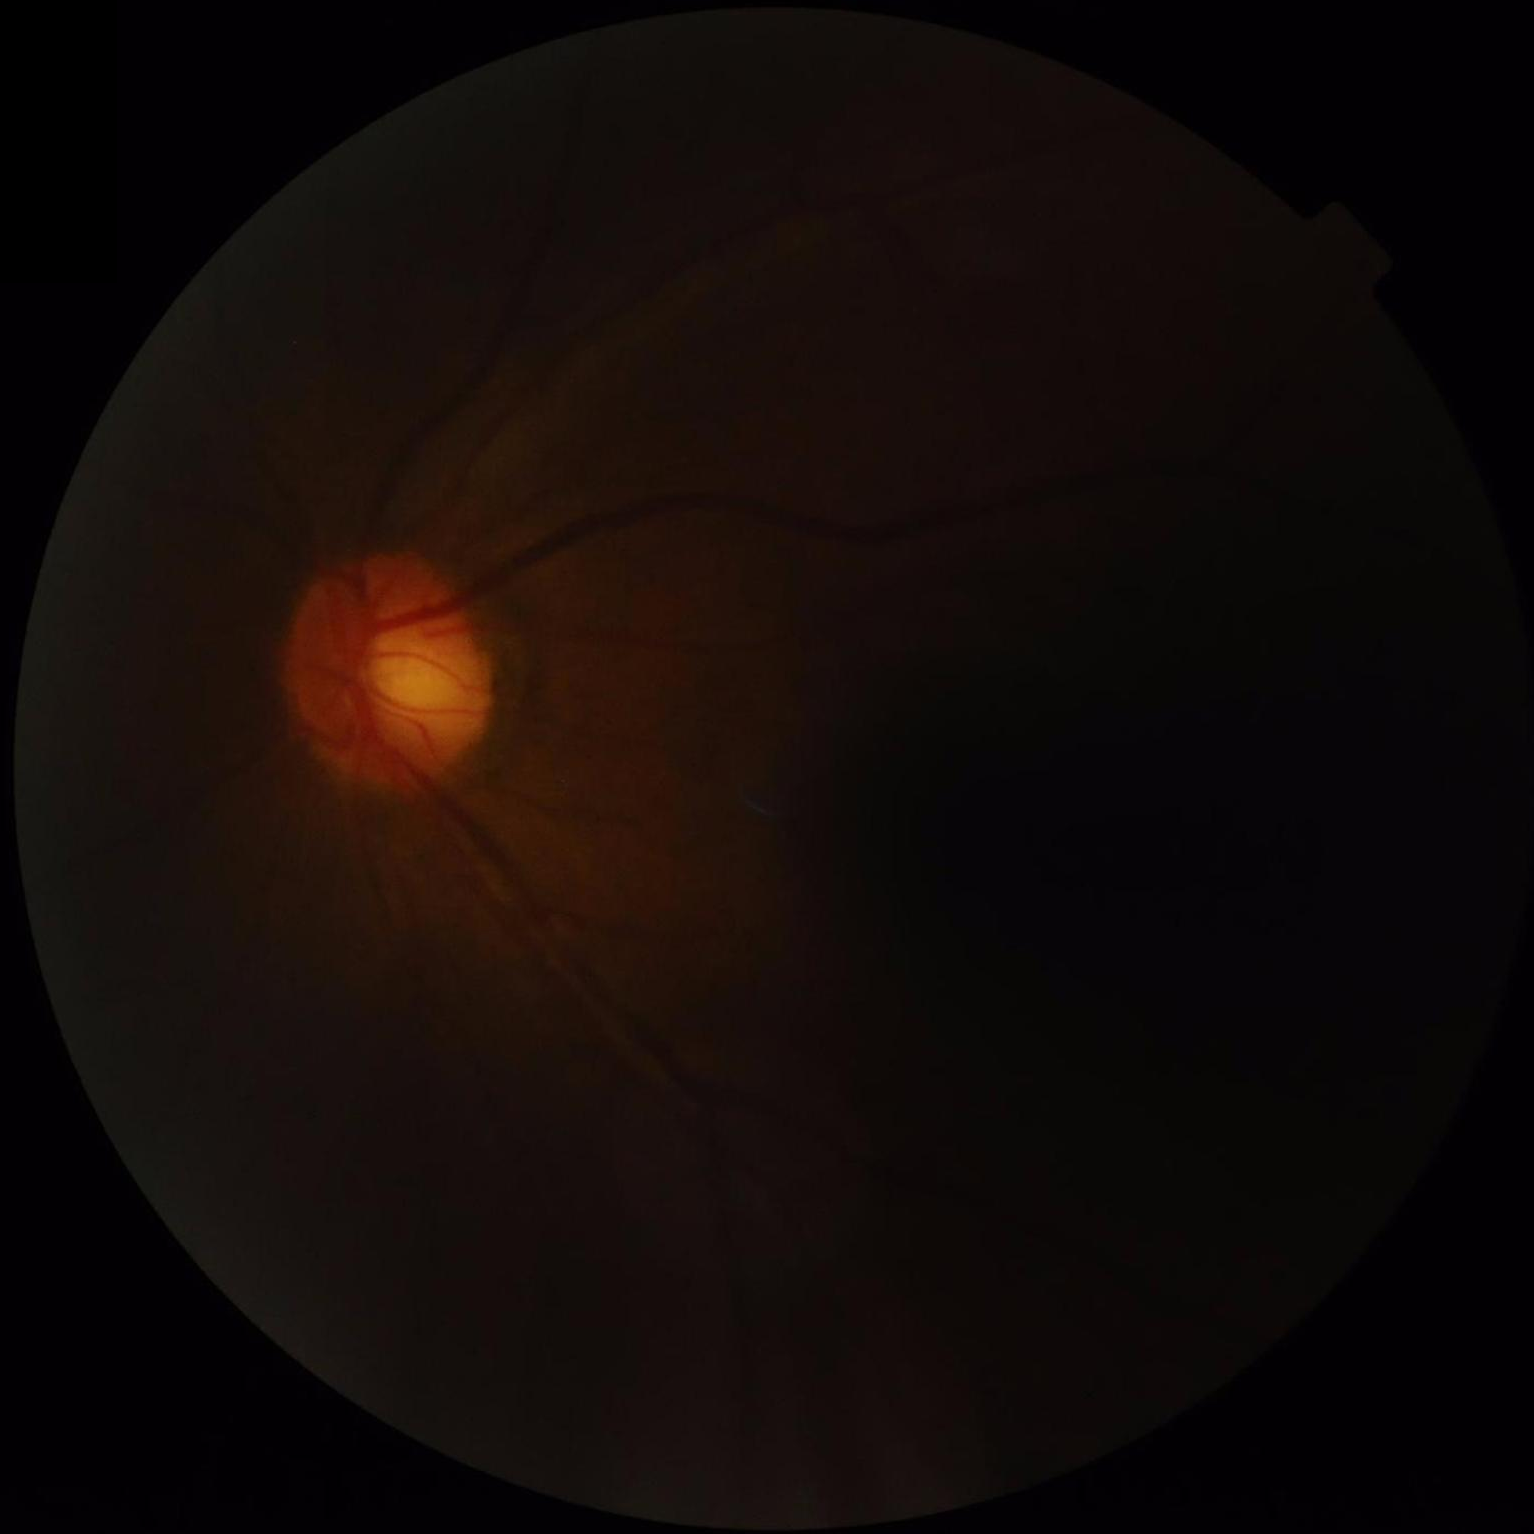 Image quality: illumination: poor; clarity: blurry; contrast: reduced; overall: inadequate.